45 degree fundus photograph, no pharmacologic dilation, posterior pole color fundus photograph
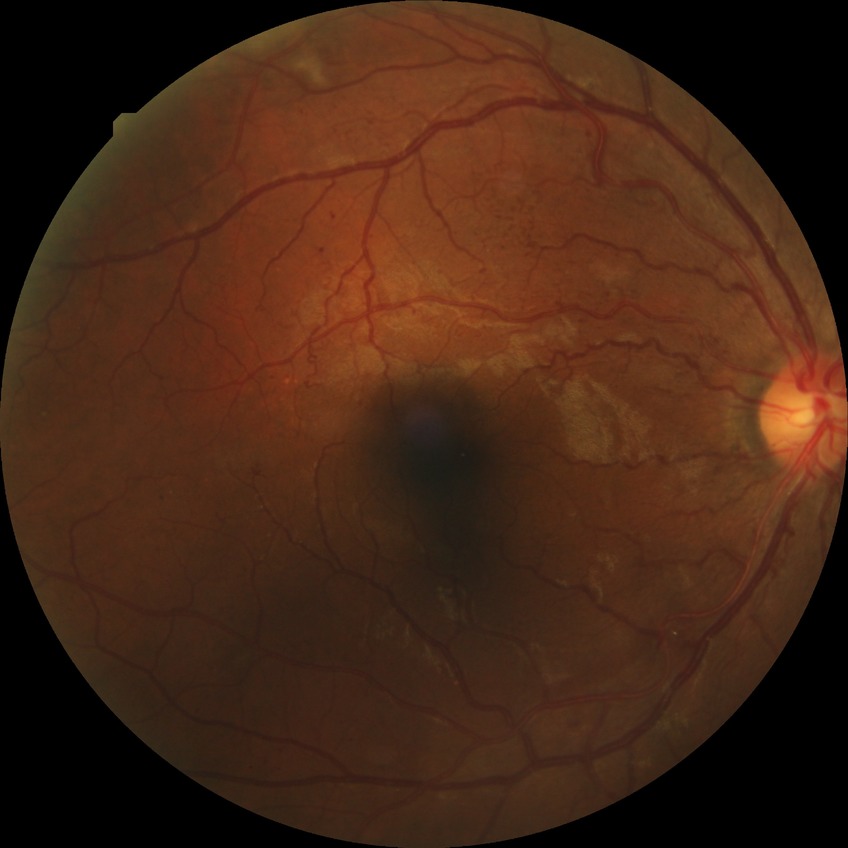
Modified Davis grading: pre-proliferative diabetic retinopathy.